DR severity per modified Davis staging: 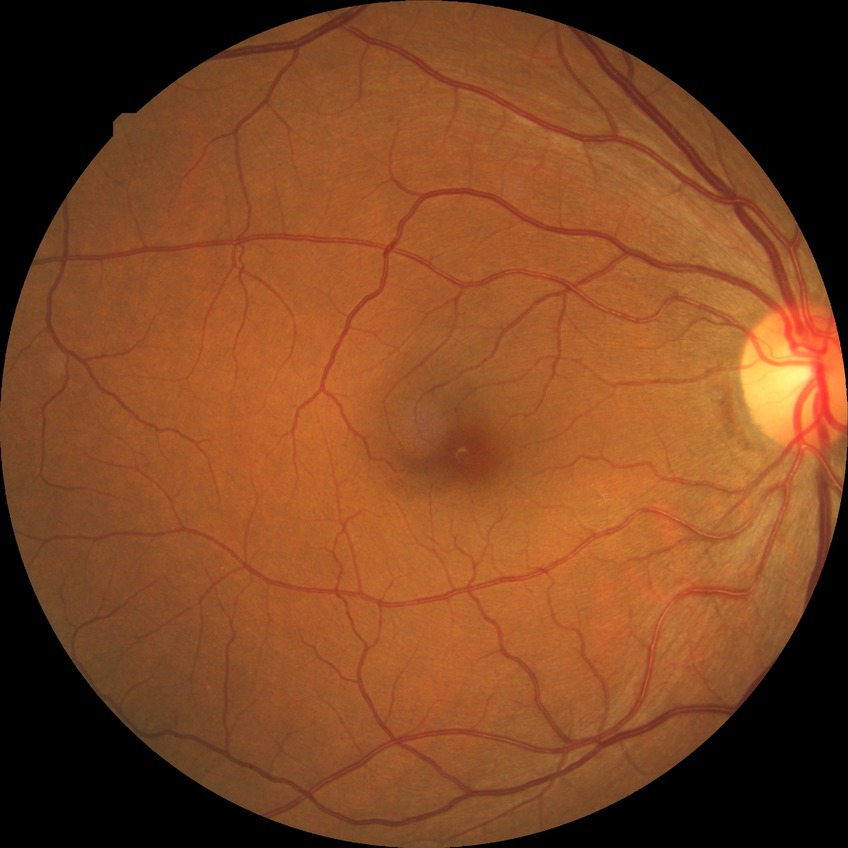   davis_grade: NDR (no diabetic retinopathy)